Fundus photo. Modified Davis grading. 45° FOV.
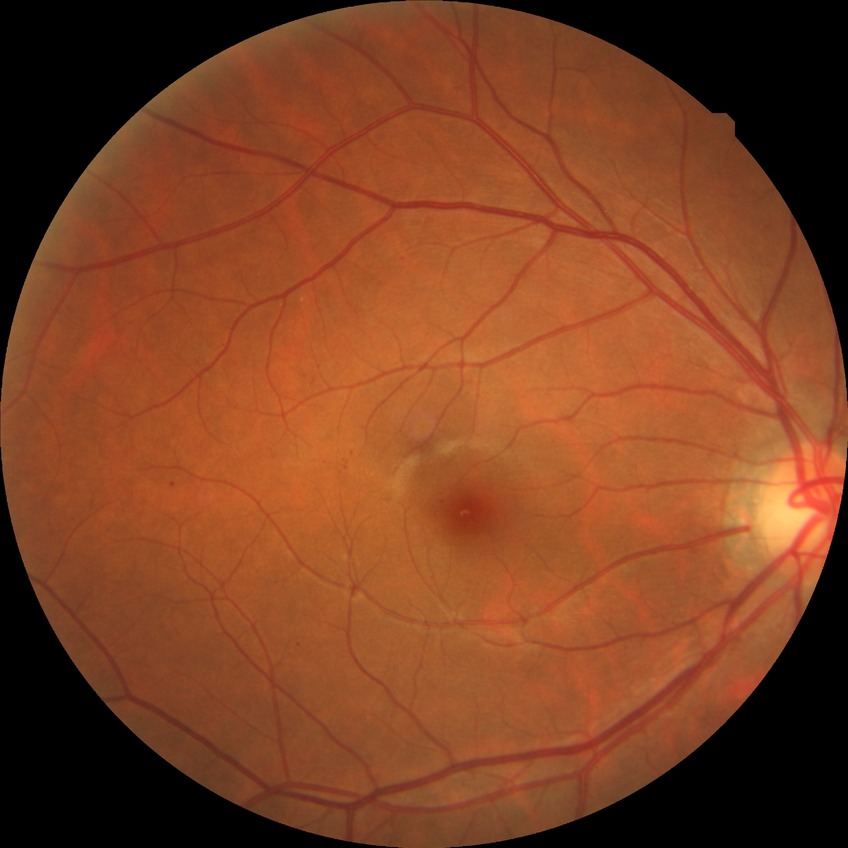 Diabetic retinopathy (DR): simple diabetic retinopathy (SDR).